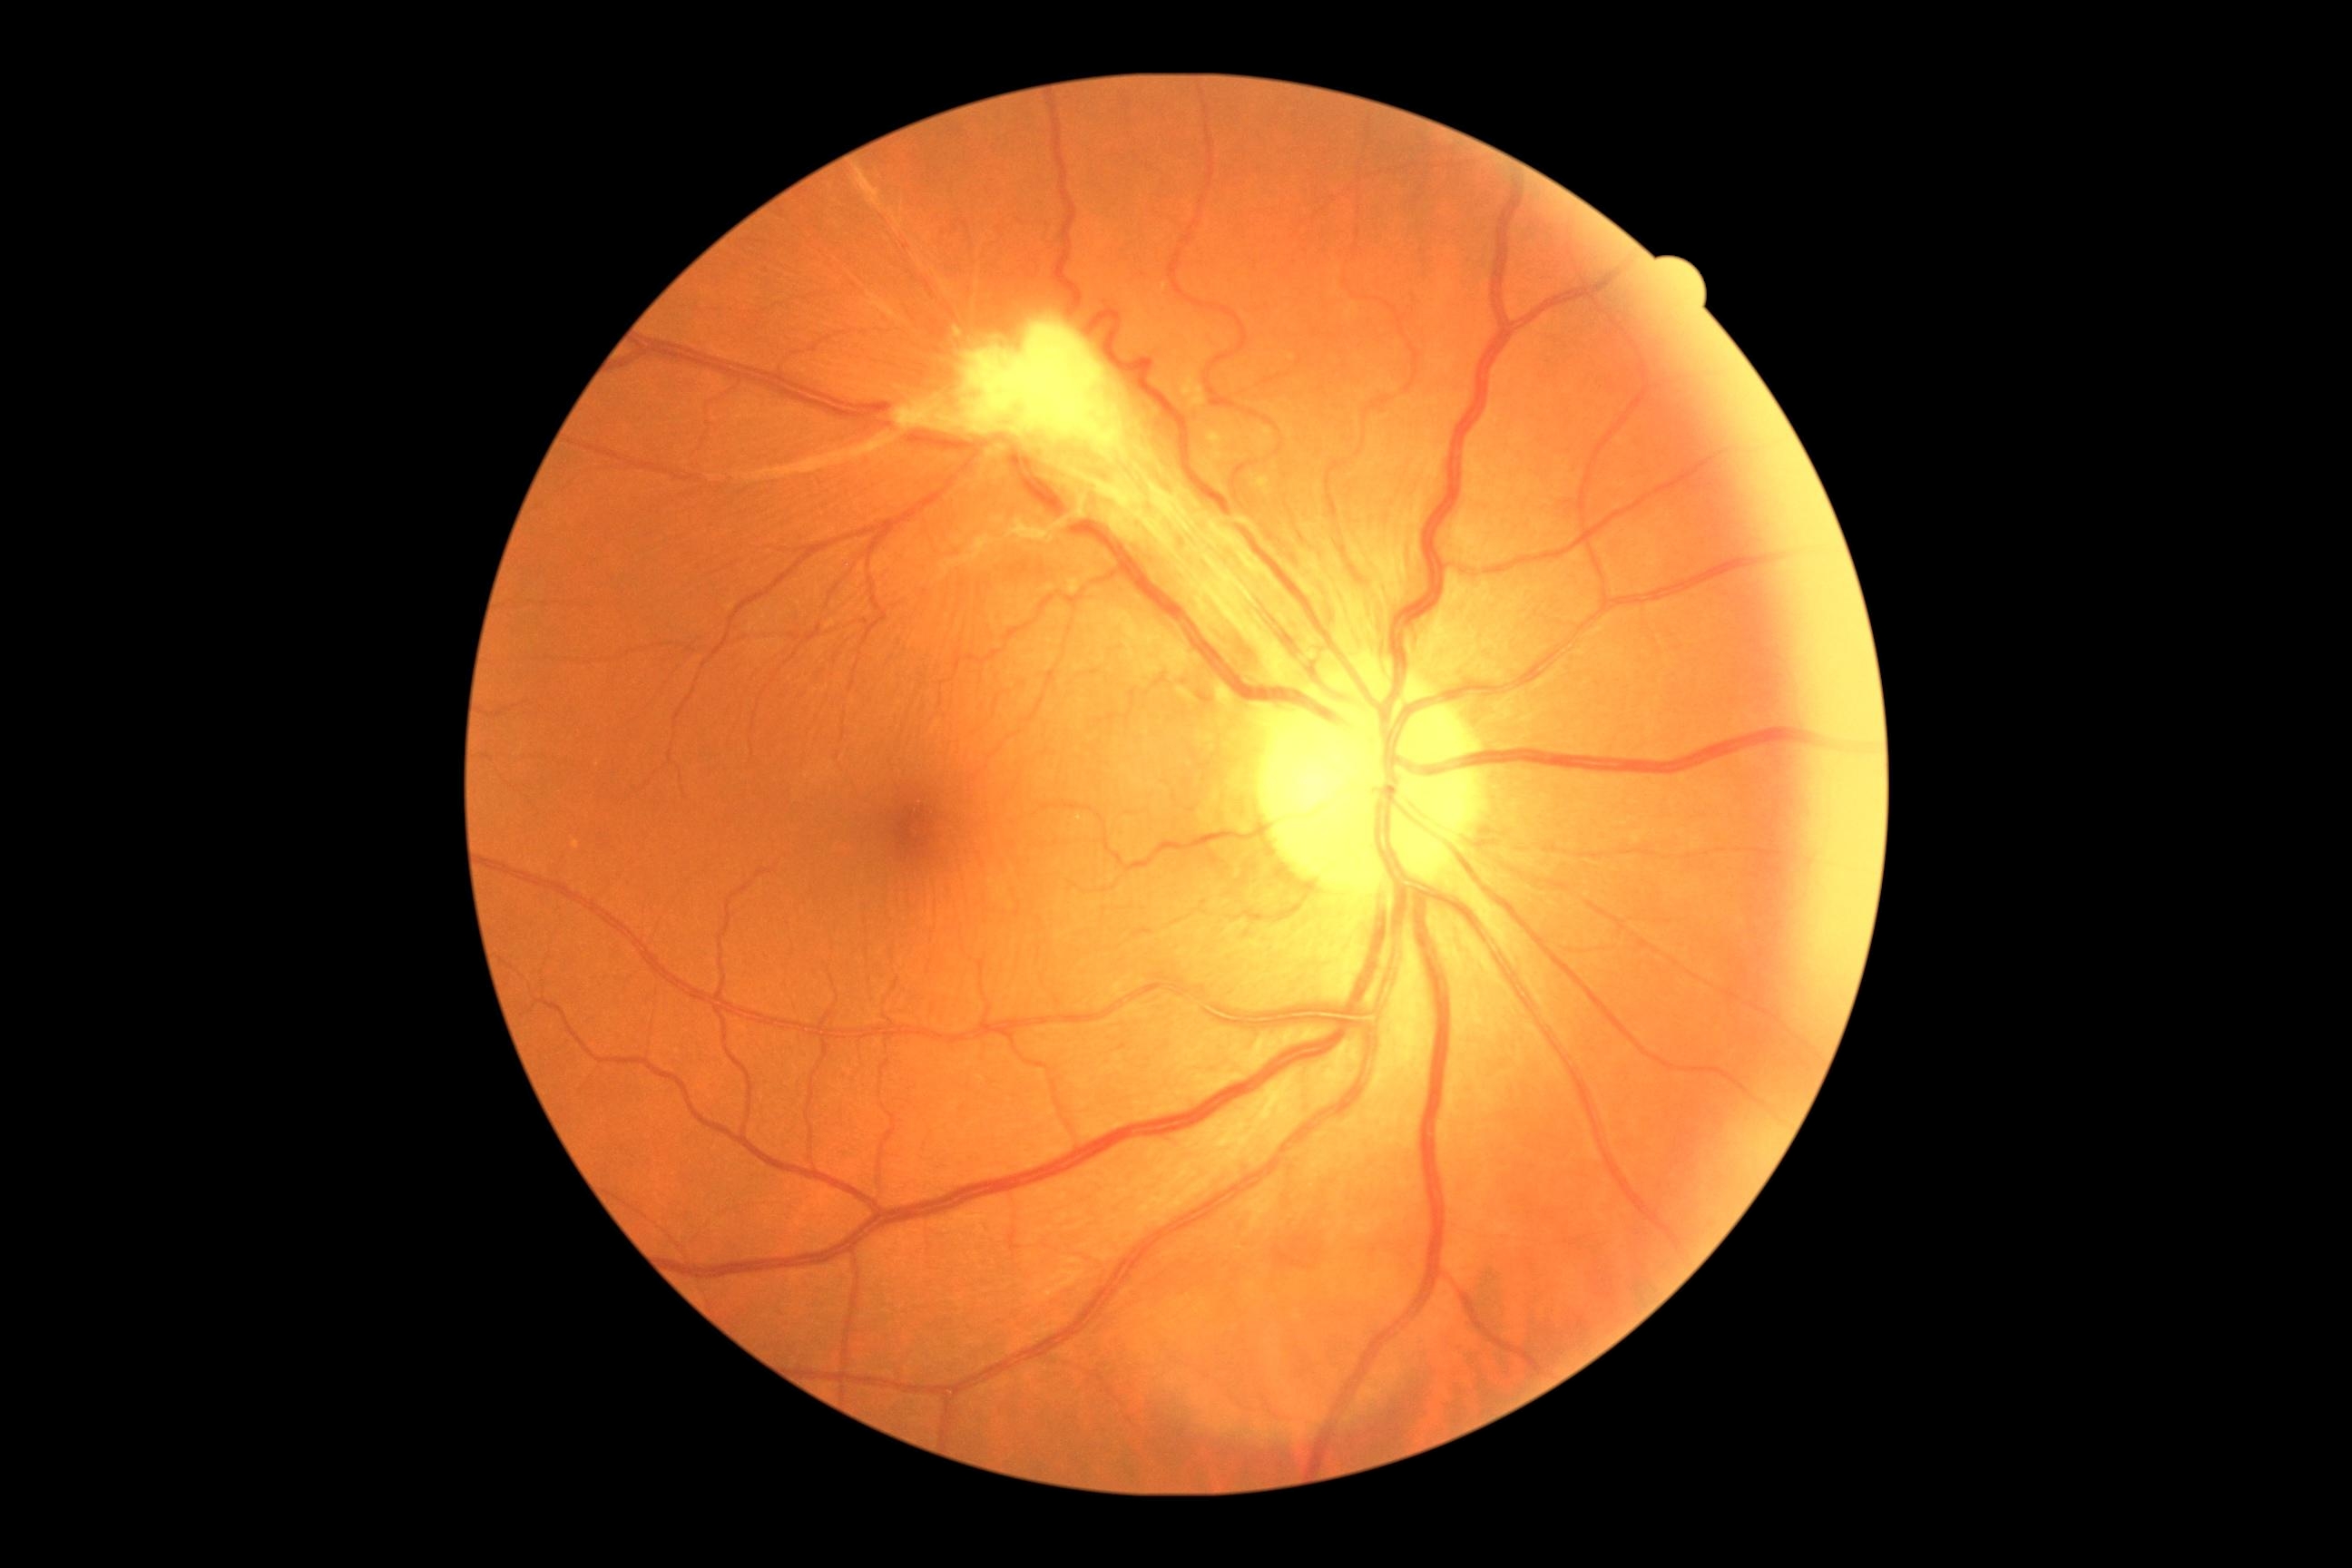 dr_category: proliferative diabetic retinopathy
dr_grade: grade 4 (PDR)